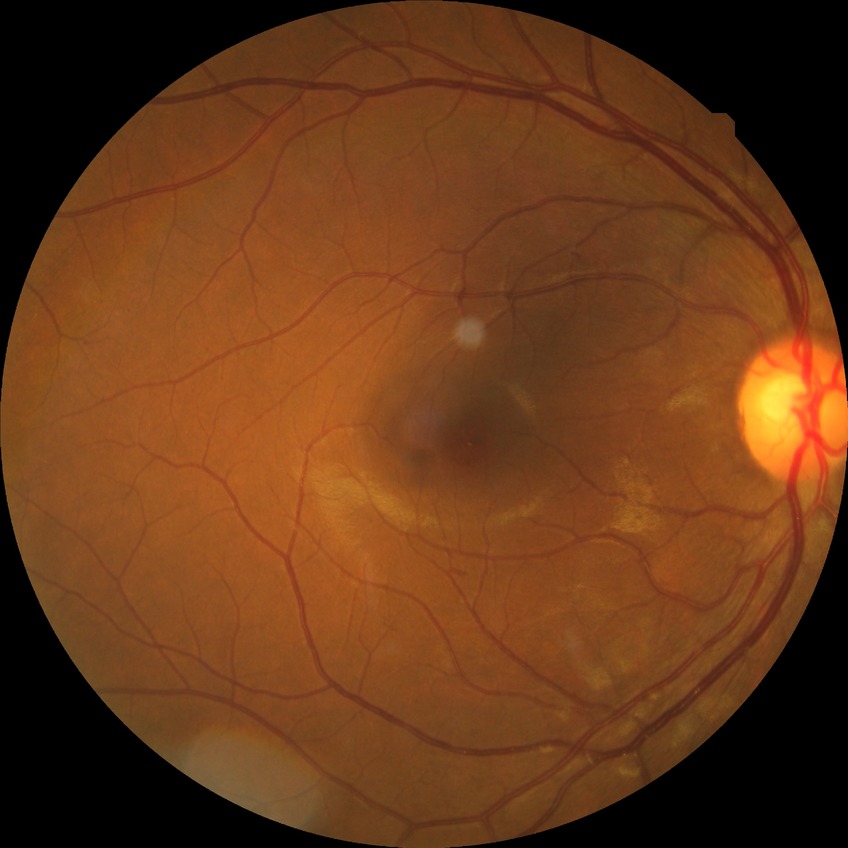 Retinopathy stage is no diabetic retinopathy.